848 x 848 pixels
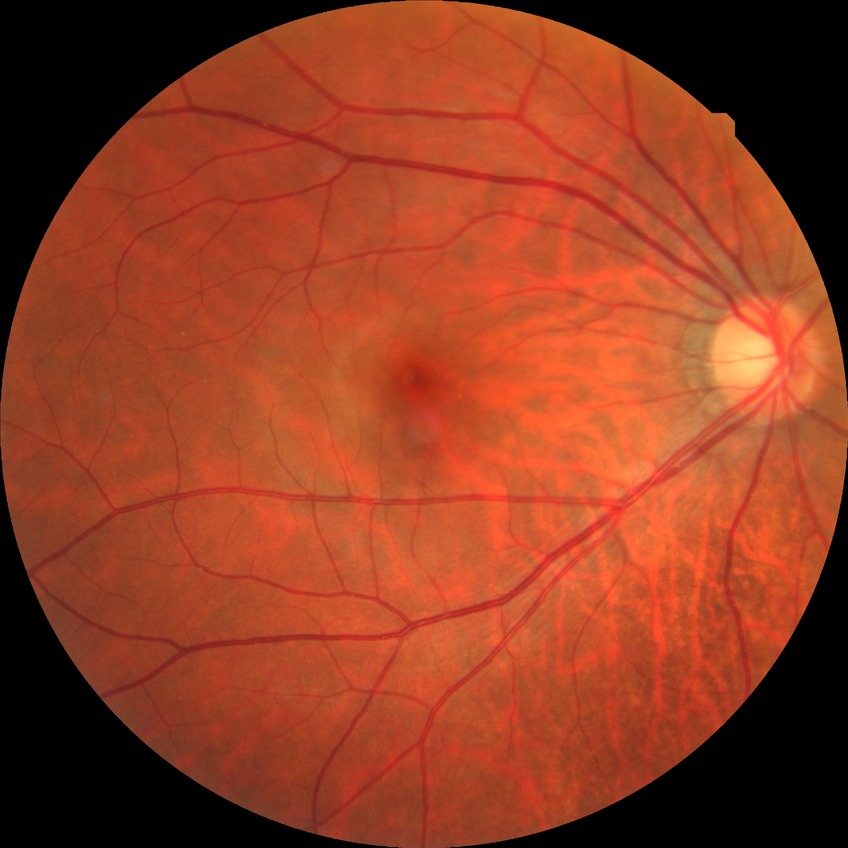 diabetic retinopathy grade = no diabetic retinopathy.